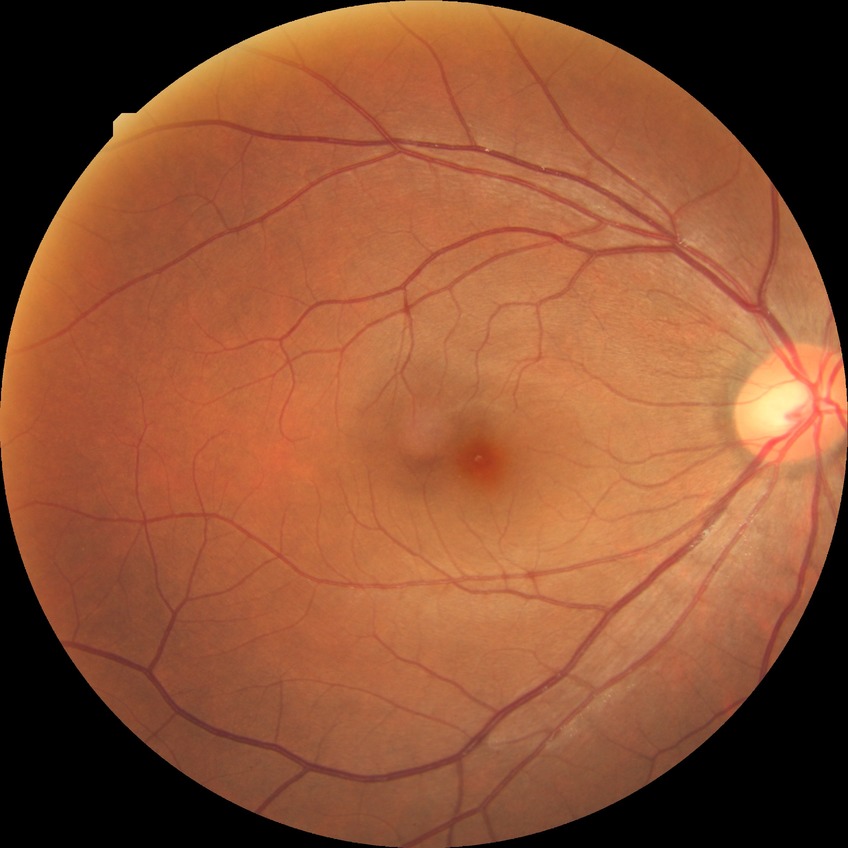

The retinopathy is classified as non-proliferative diabetic retinopathy.
Davis grade is SDR.